Image size 1440x1080; pediatric wide-field fundus photograph
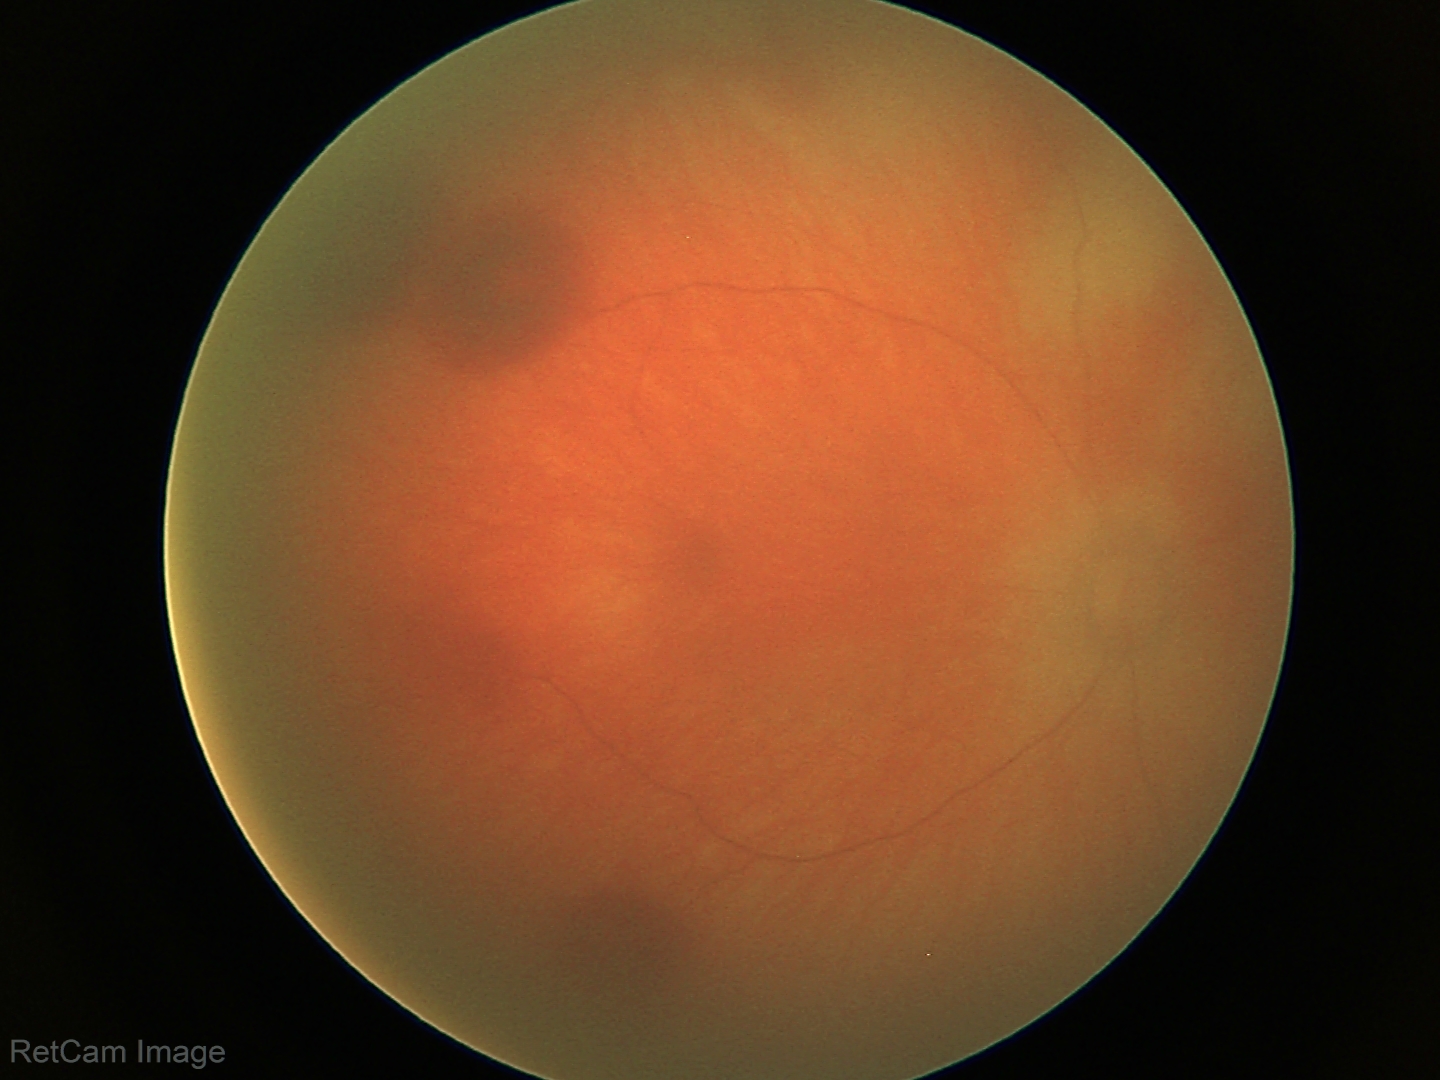

Impression: retinal hemorrhages.